Modified Davis classification
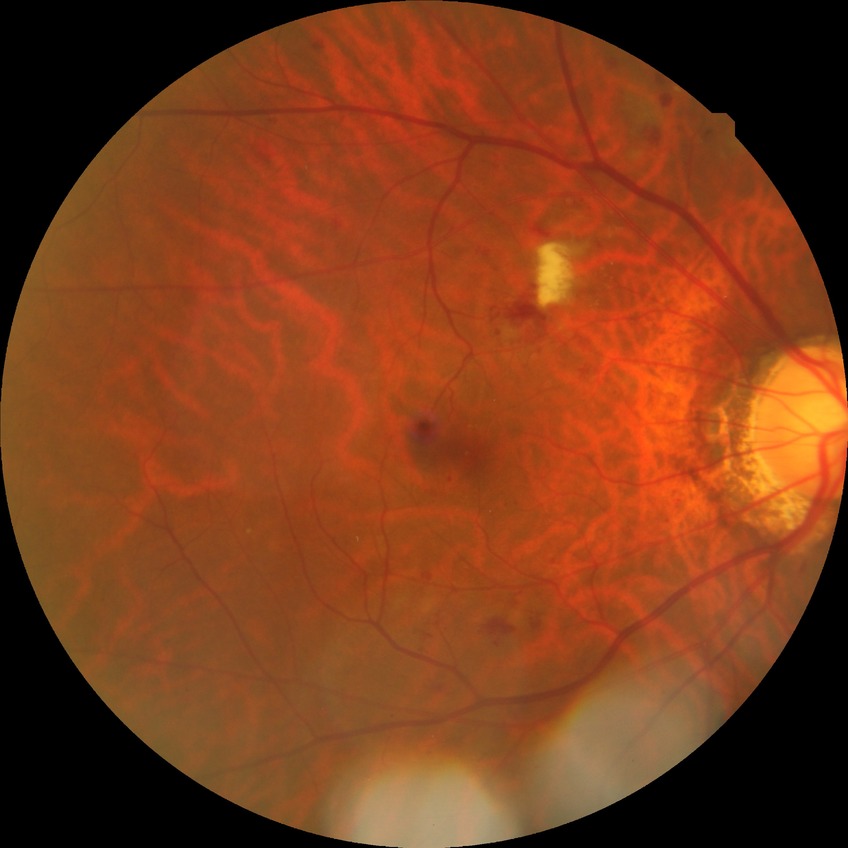 diabetic retinopathy (DR): pre-proliferative diabetic retinopathy (PPDR).